Retinal fundus photograph, 45° FOV, image size 848x848
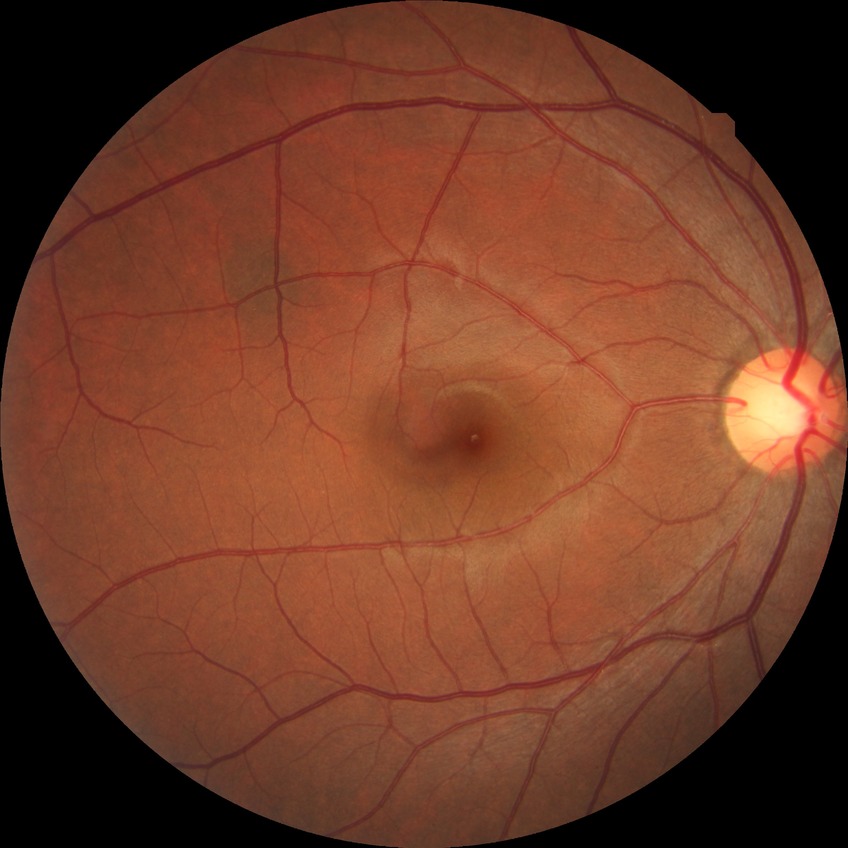

davis_grade: NDR (no diabetic retinopathy)